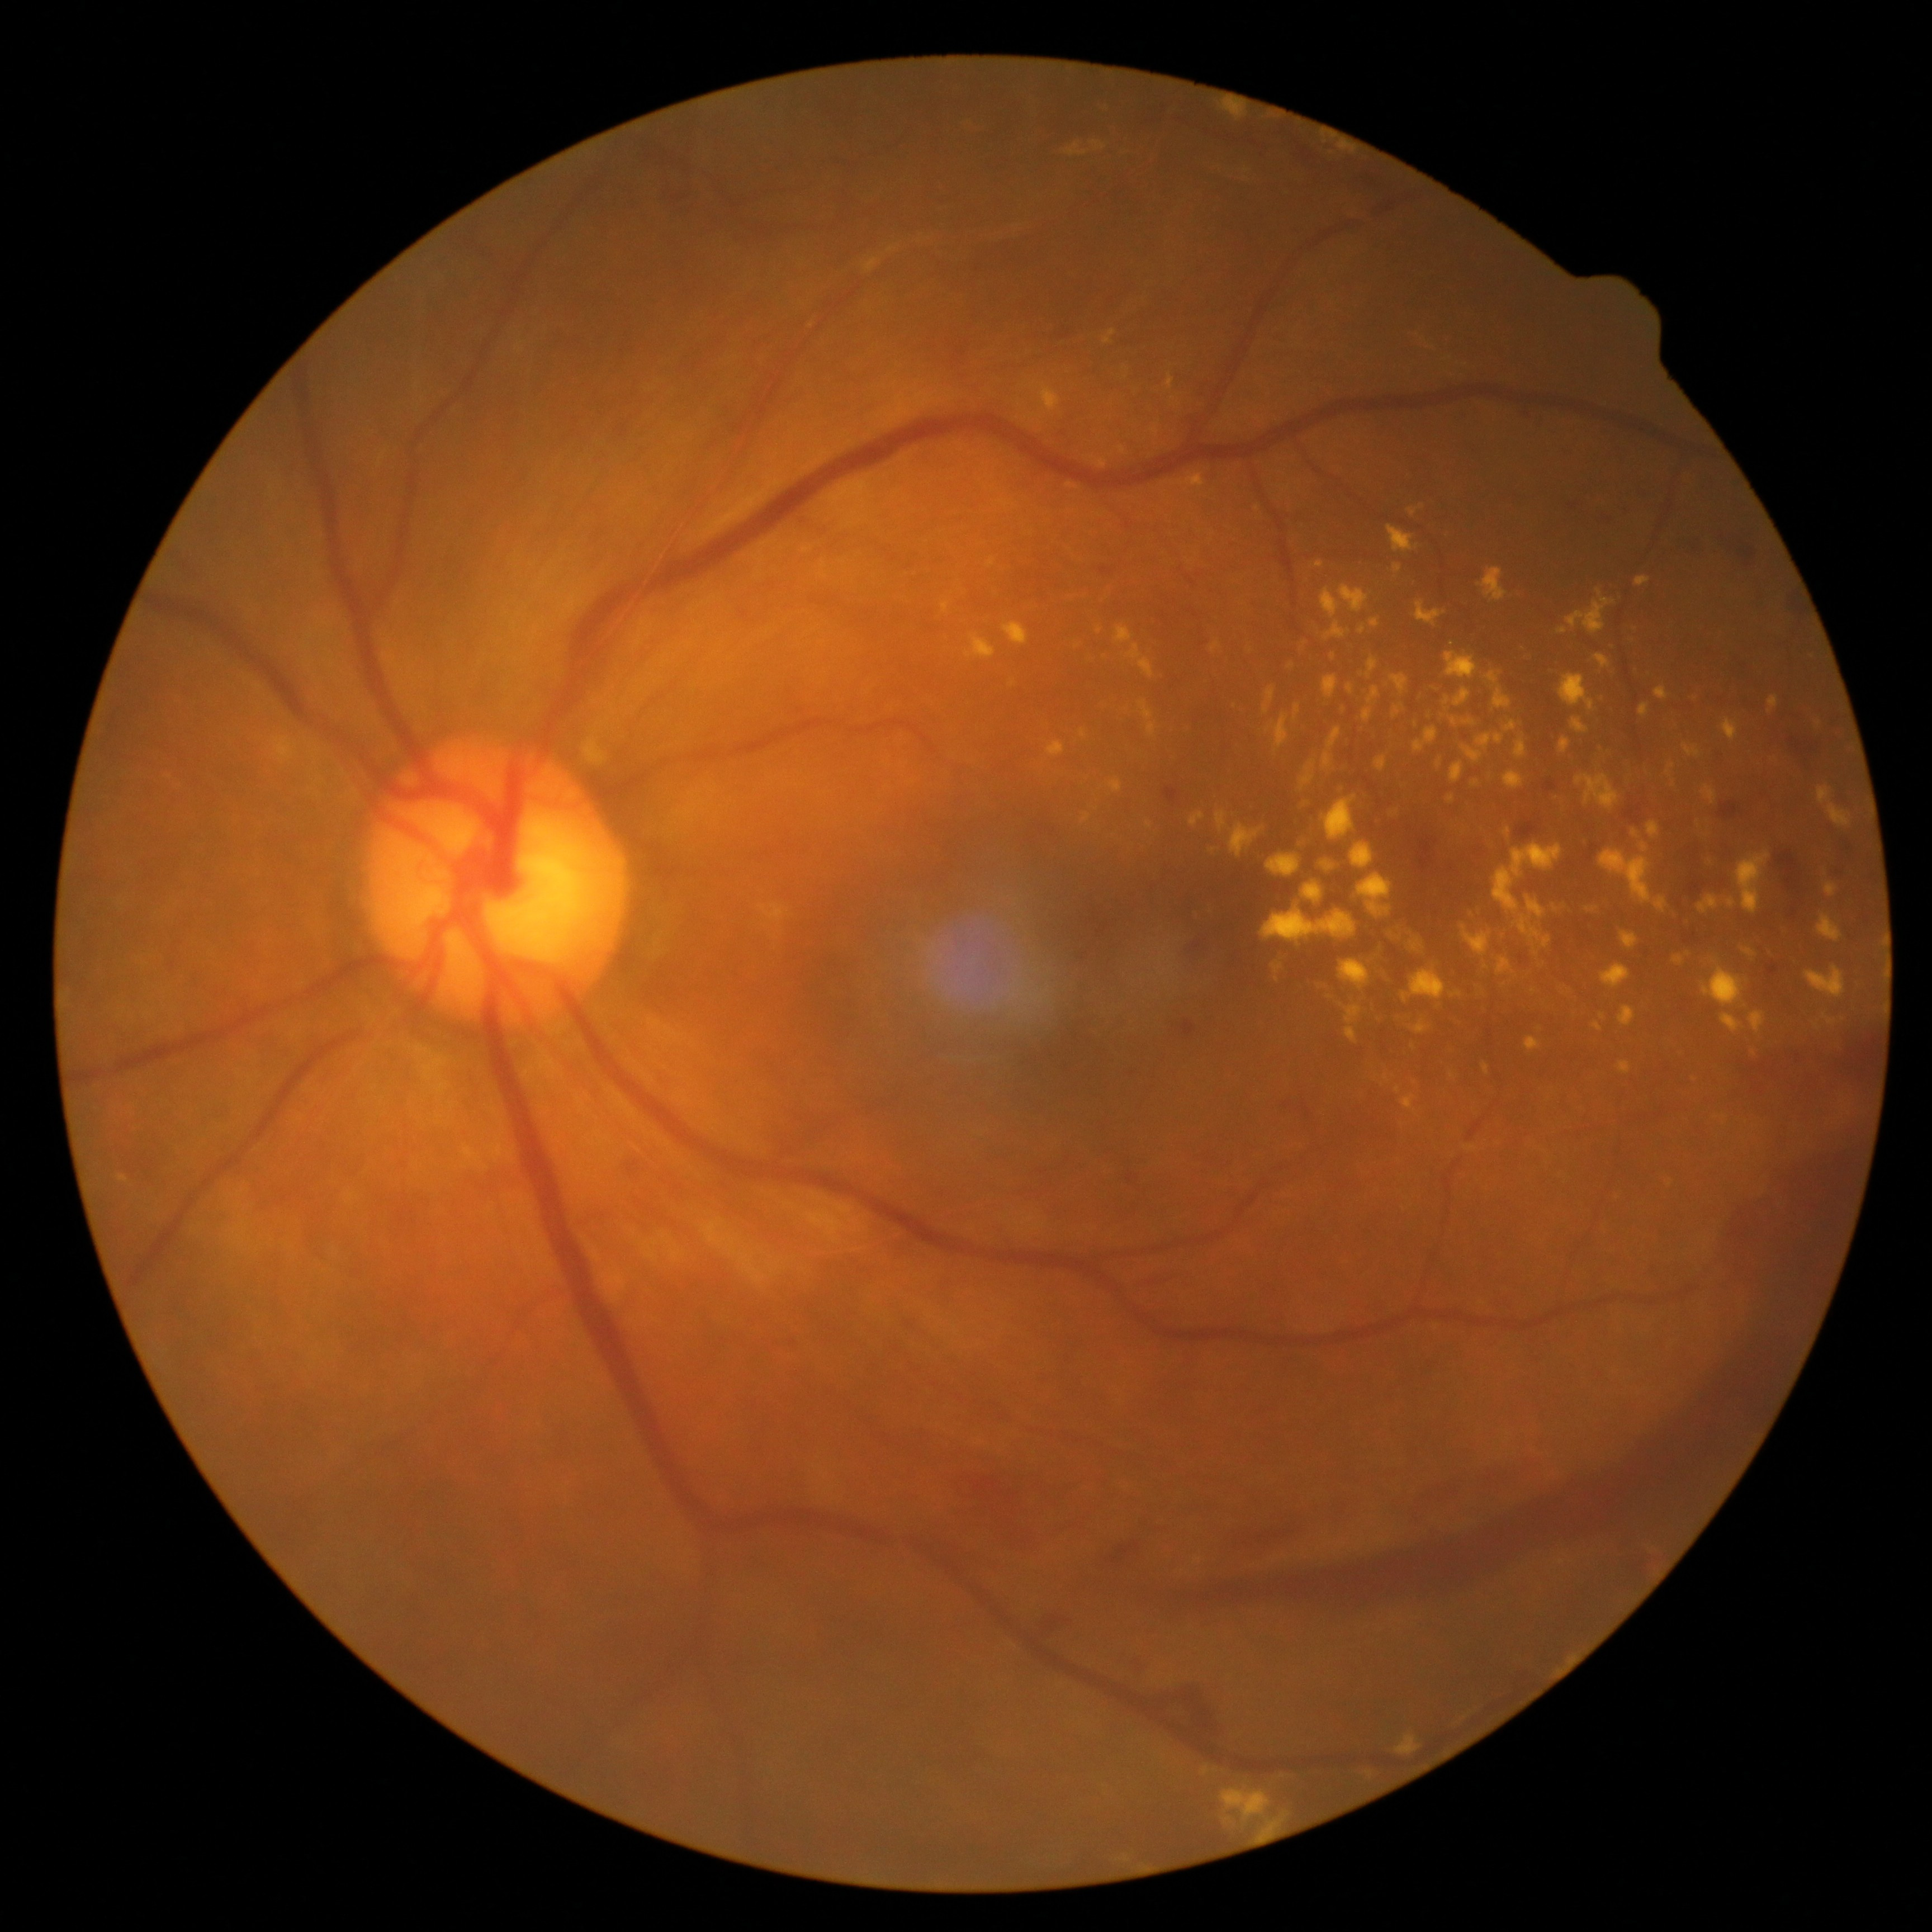 Diabetic retinopathy (DR): proliferative diabetic retinopathy (grade 4)
Lesions identified (partial list):
hard exudates (EXs) (continued): left=1560, top=674, right=1594, bottom=712 | left=1368, top=686, right=1380, bottom=706 | left=1451, top=762, right=1465, bottom=783 | left=1114, top=626, right=1134, bottom=645 | left=1079, top=730, right=1087, bottom=738 | left=1635, top=576, right=1652, bottom=588 | left=1466, top=905, right=1478, bottom=918 | left=1668, top=1180, right=1673, bottom=1188 | left=1516, top=895, right=1551, bottom=949 | left=1703, top=851, right=1718, bottom=866 | left=1258, top=1815, right=1286, bottom=1839 | left=1465, top=1144, right=1478, bottom=1152 | left=1445, top=652, right=1478, bottom=679 | left=1640, top=842, right=1650, bottom=854 | left=1475, top=733, right=1504, bottom=751 | left=1699, top=896, right=1718, bottom=914 | left=1436, top=760, right=1443, bottom=769
Small EXs near (1412, 1047) | (1534, 990)